1240x1240; wide-field fundus photograph from neonatal ROP screening; camera: Phoenix ICON (100° FOV): 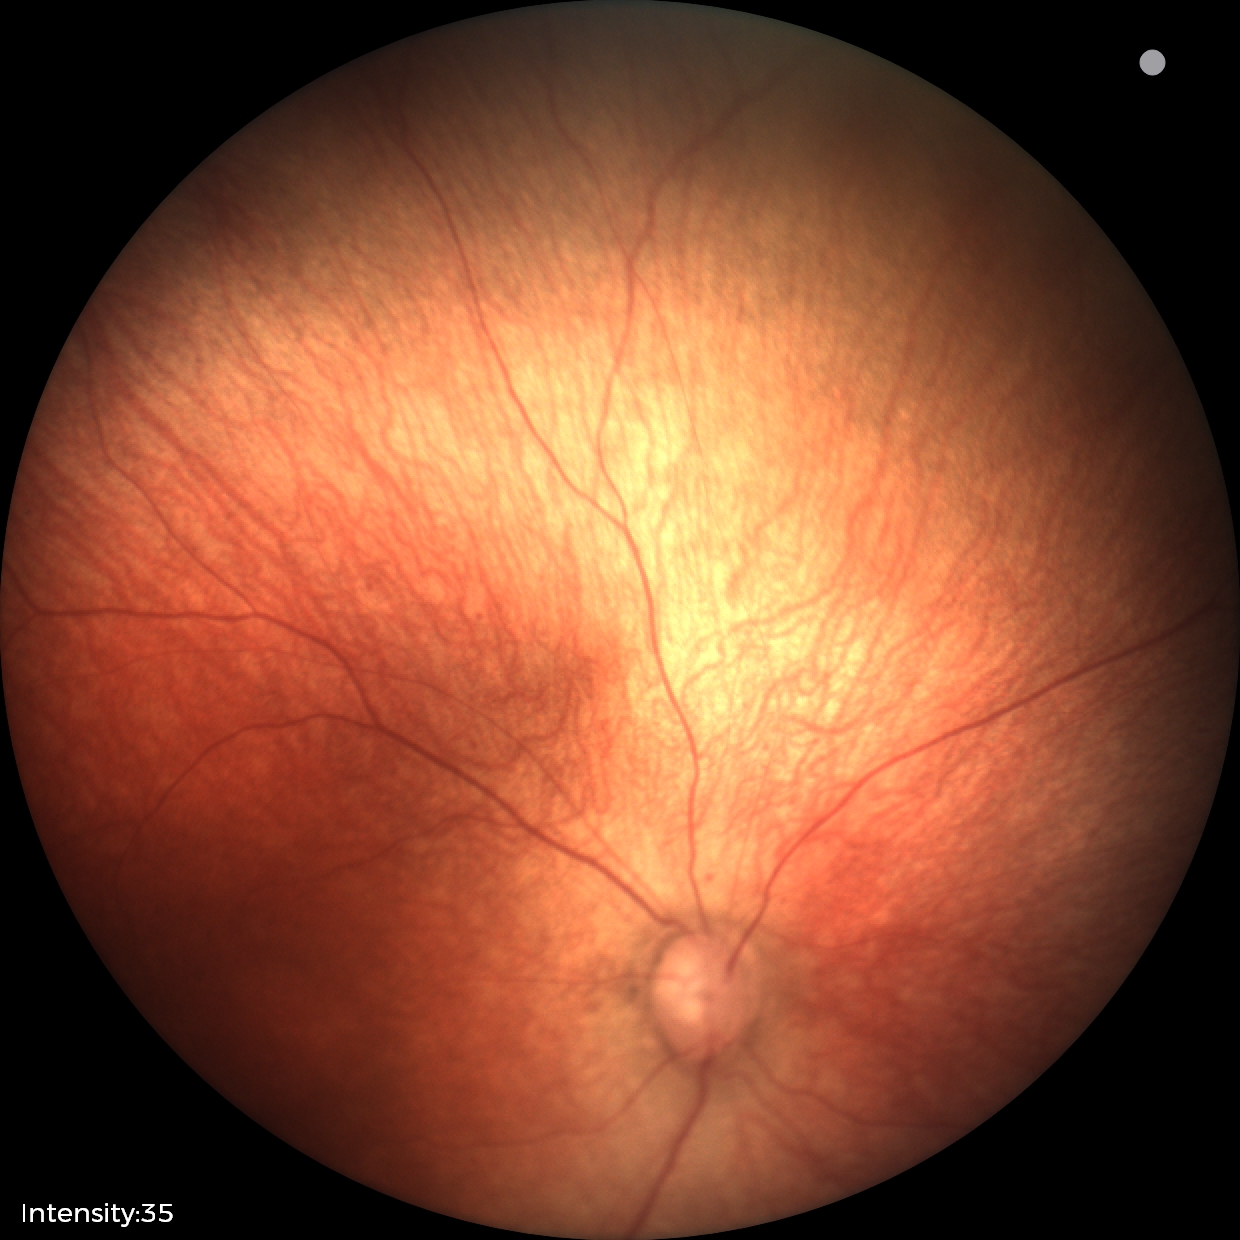
Impression: normal.